2352 by 1568 pixels, 45° FOV: 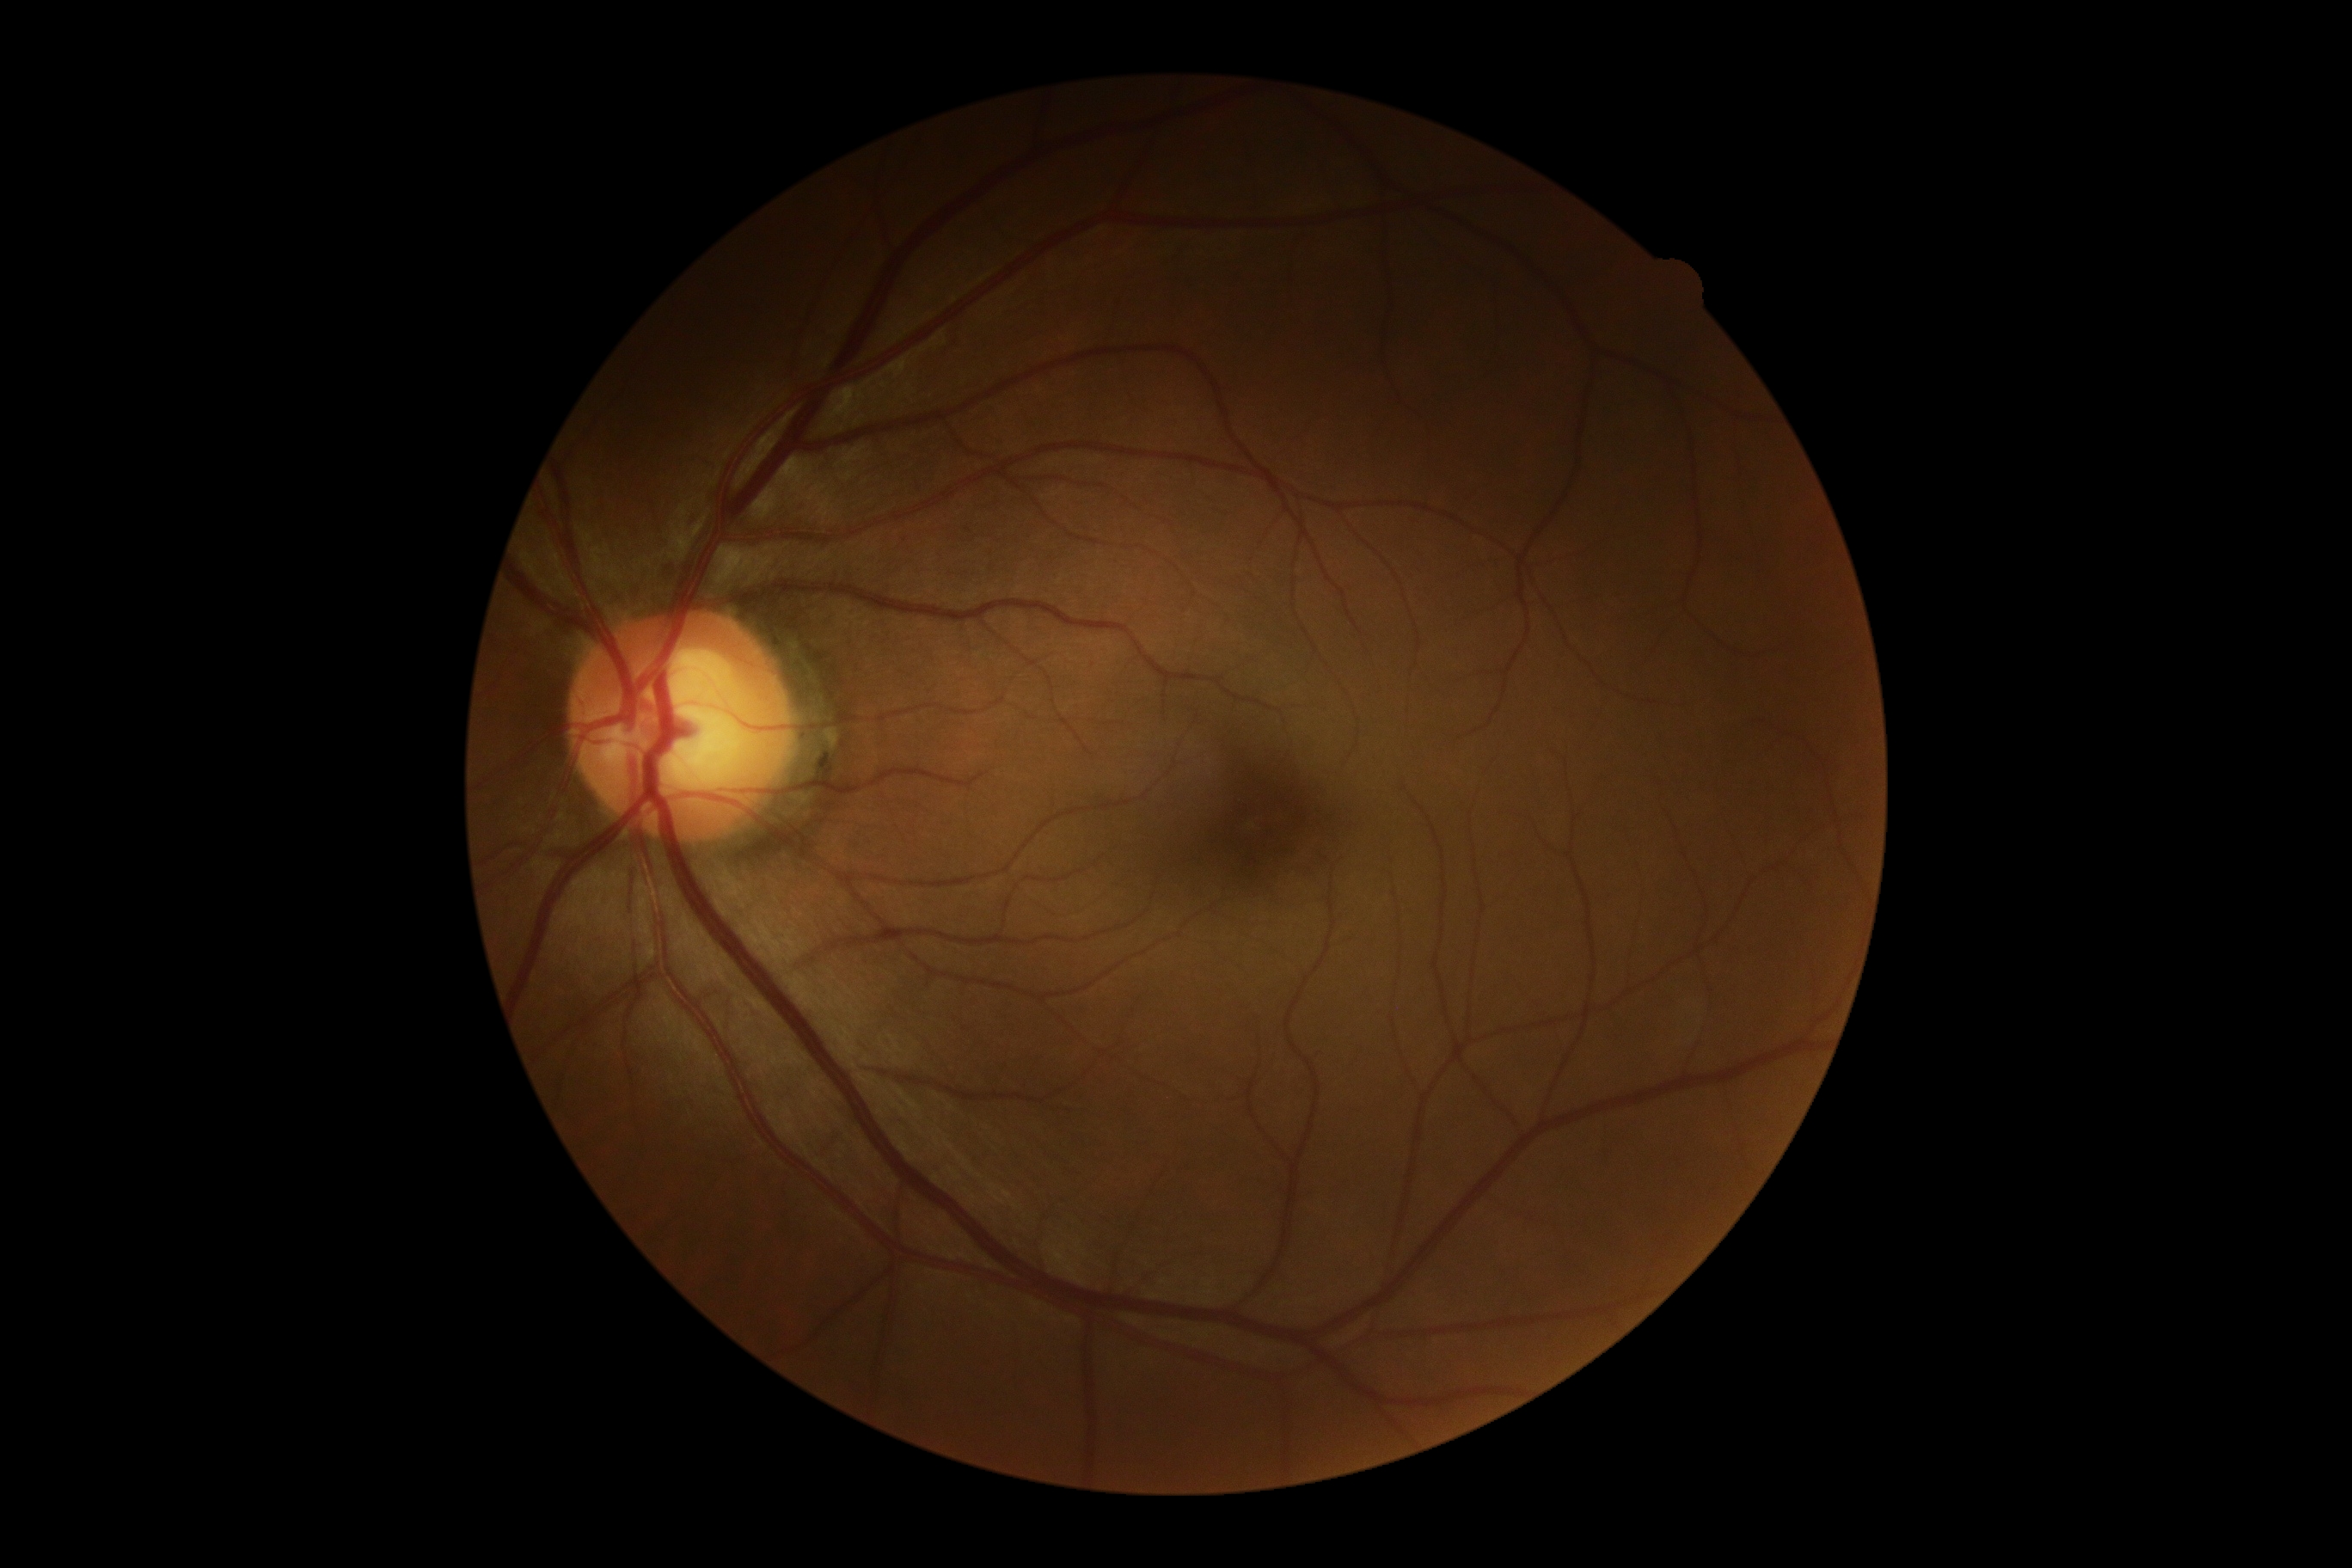
DR is 0/4.